1440x1080px · pediatric wide-field fundus photograph · Natus RetCam Envision, 130° FOV
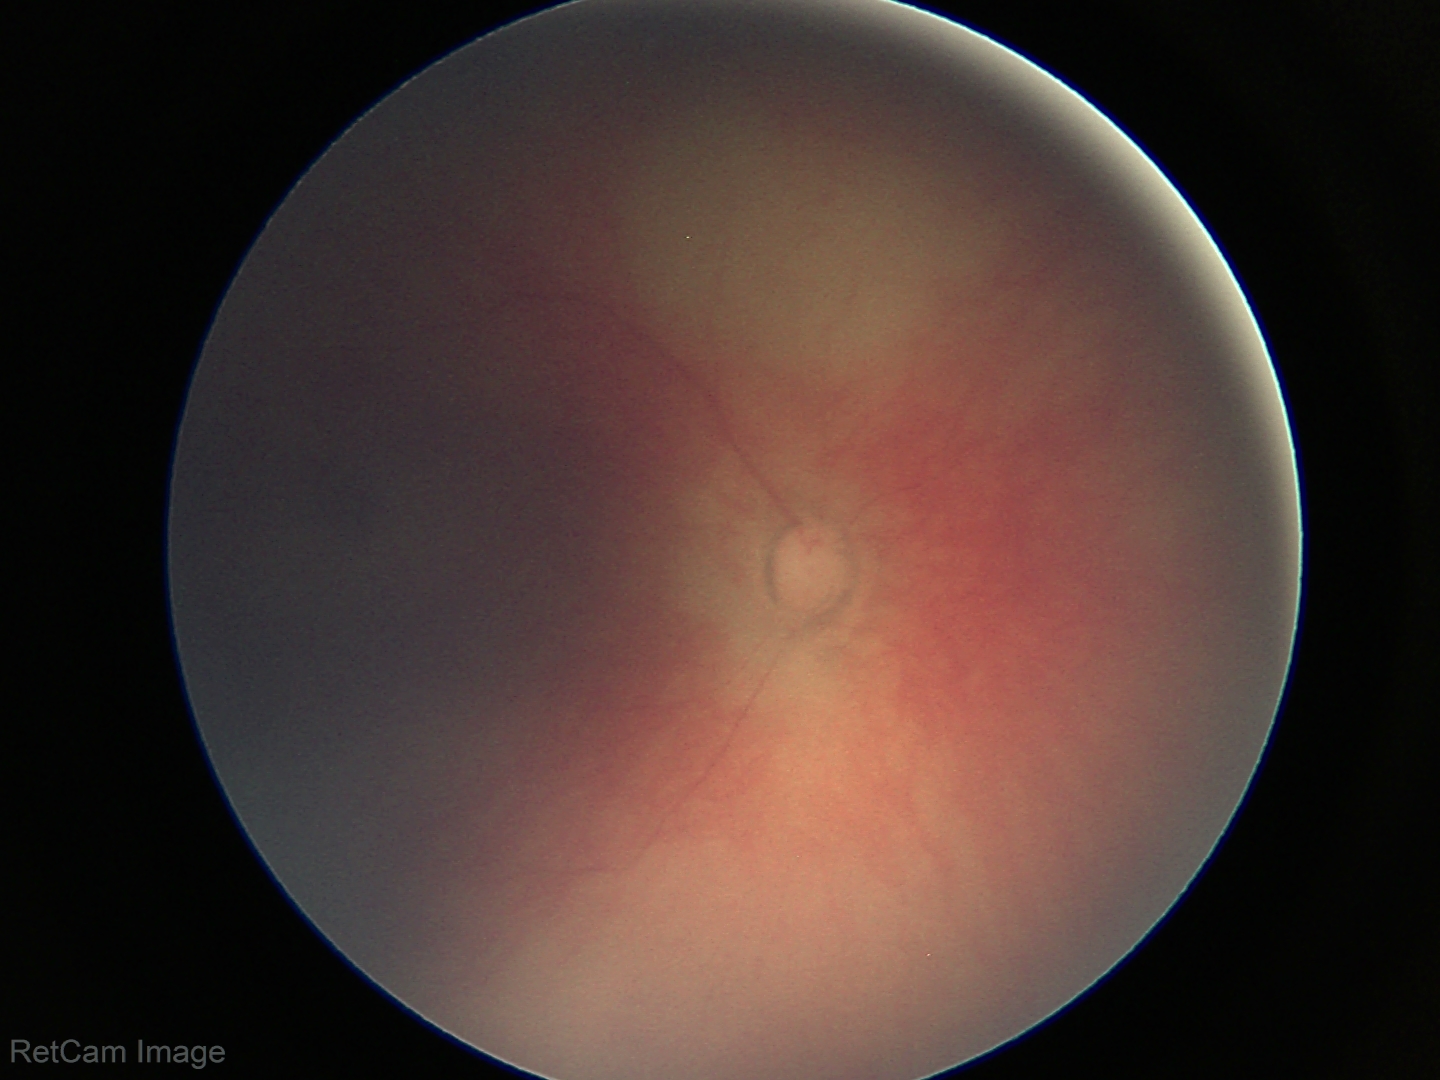 Assessment: physiological appearance.